Color fundus photograph: 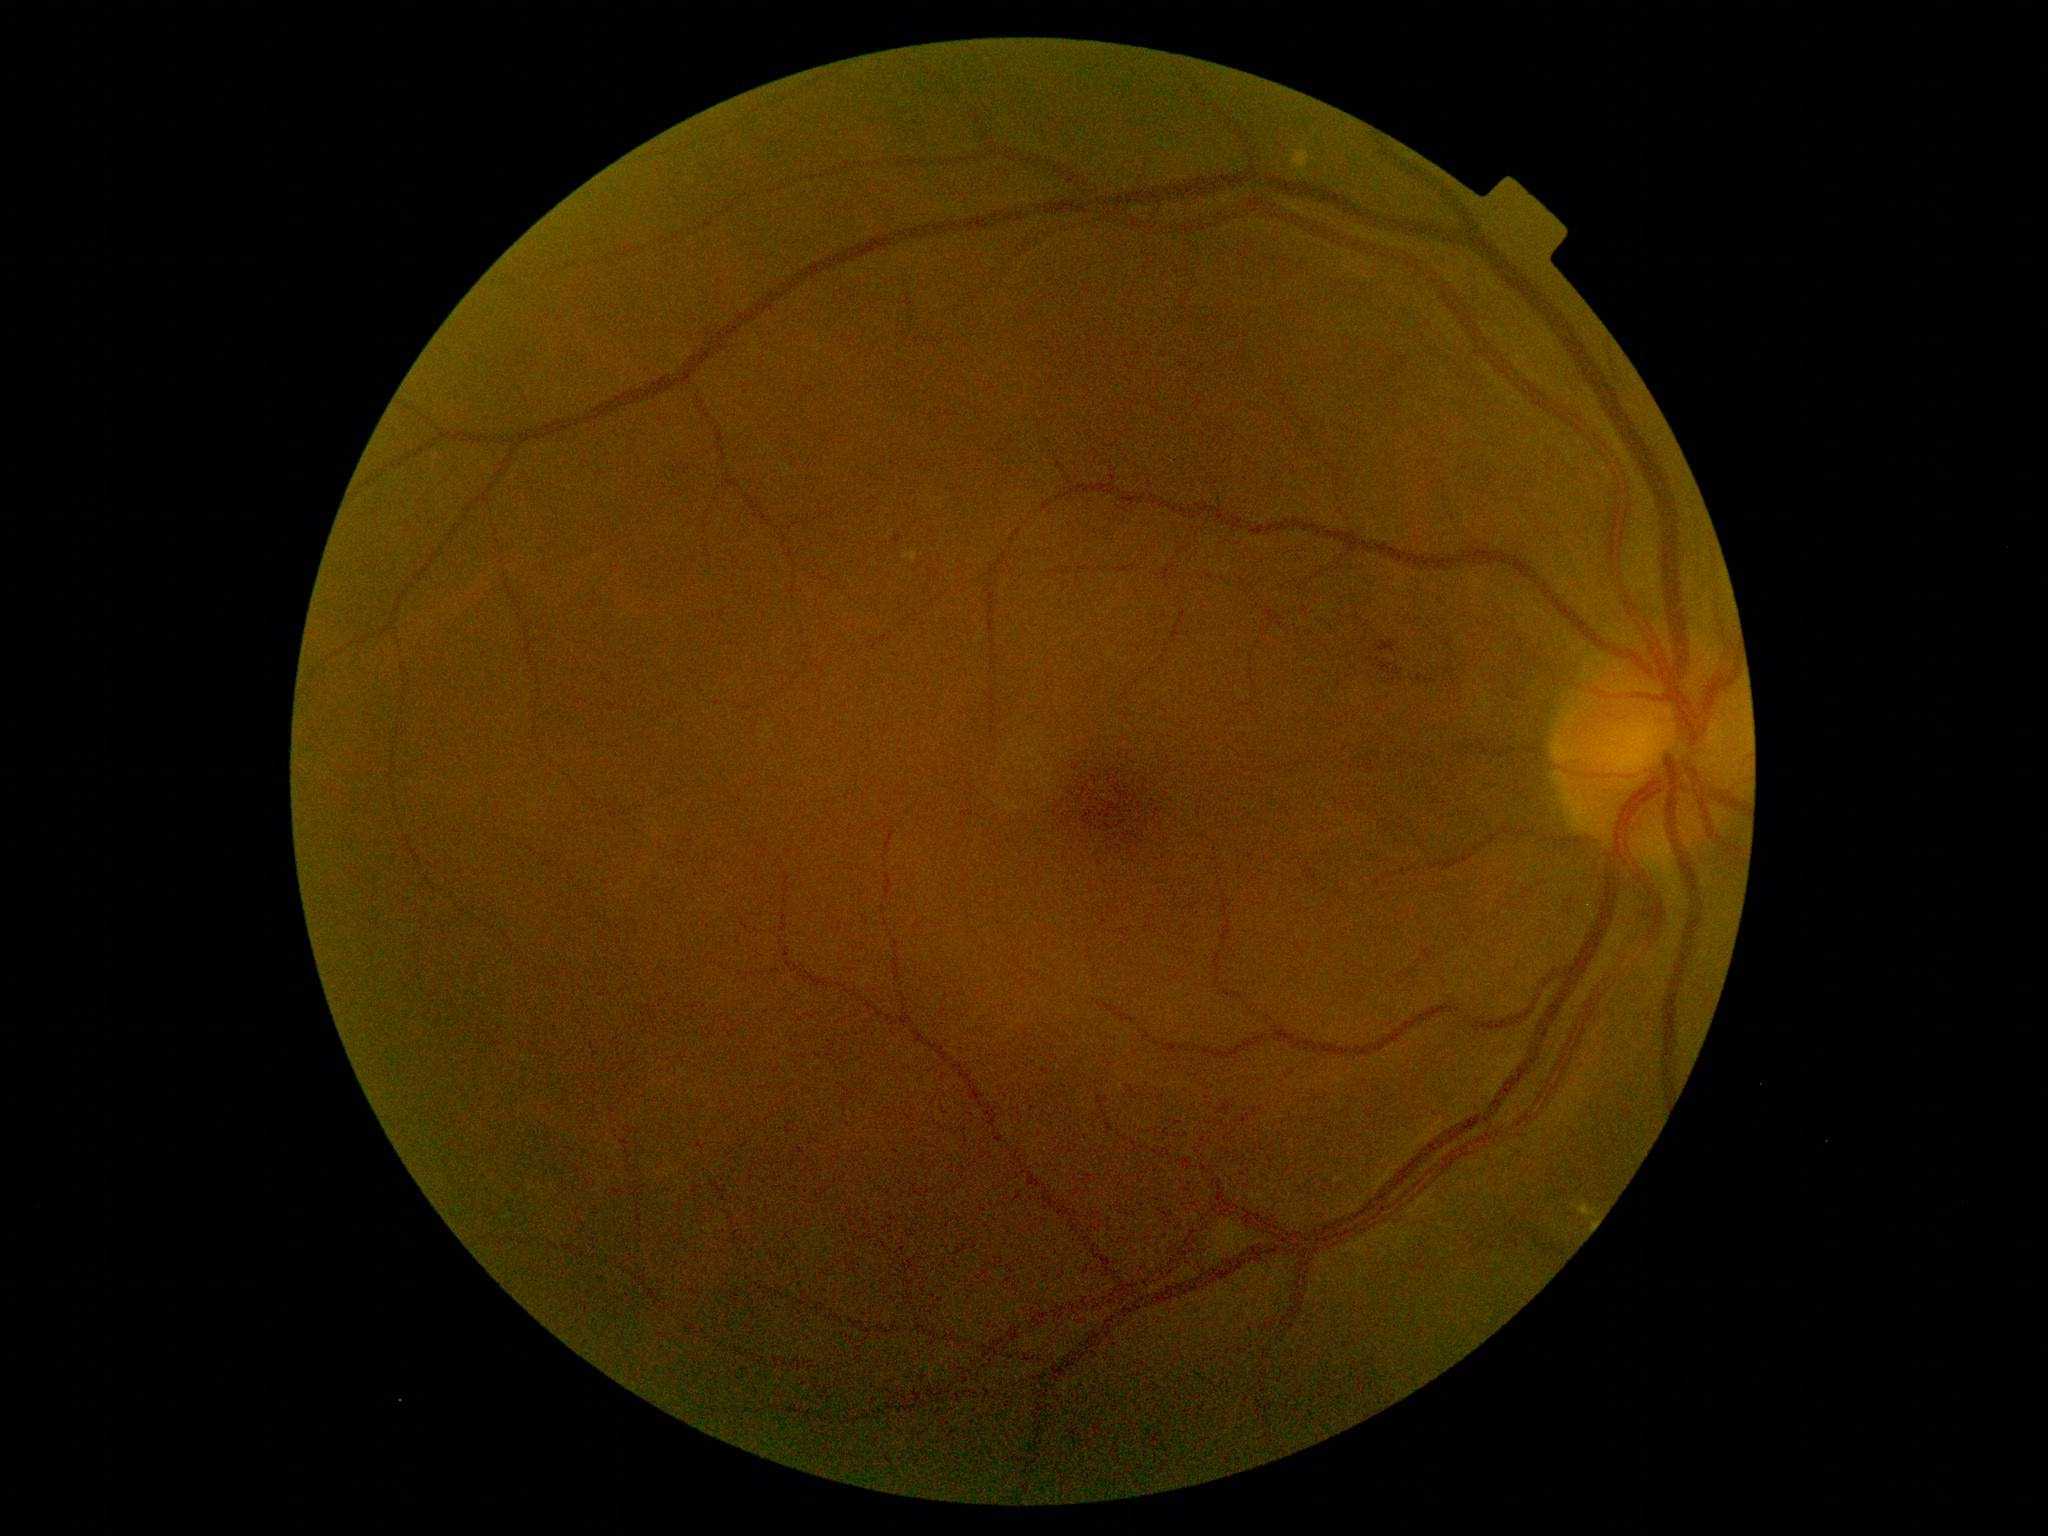
{
  "dr_grade": "2 — more than just microaneurysms but less than severe NPDR"
}